Color fundus image — 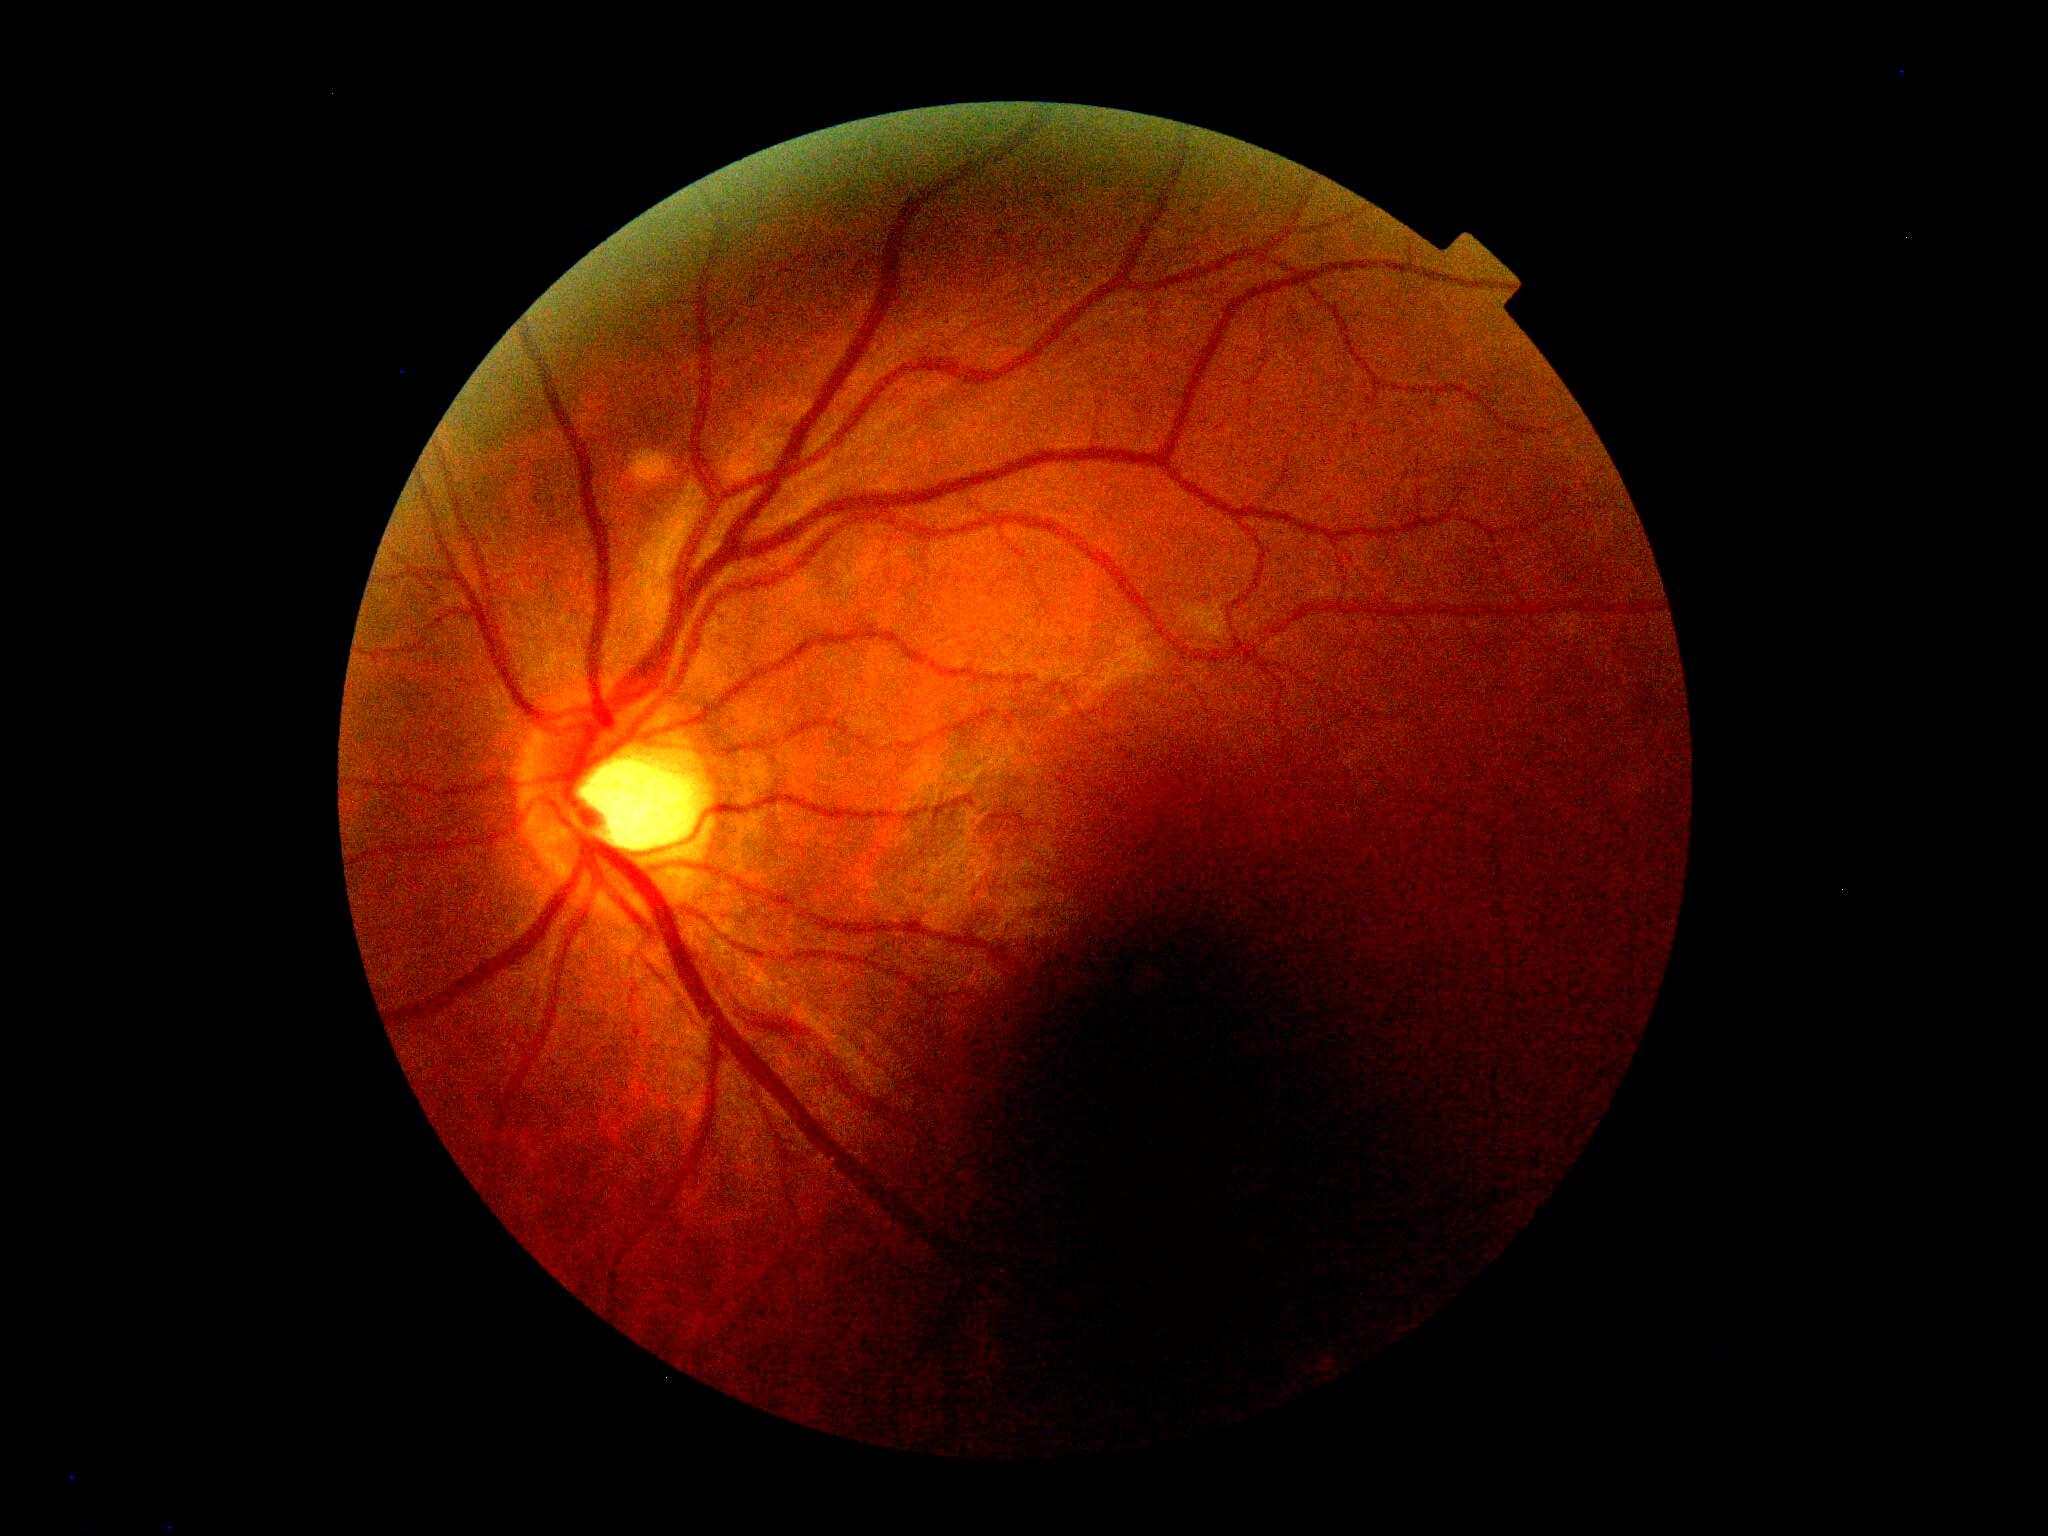 Retinopathy is grade 0 — no visible signs of diabetic retinopathy.